1240x1240px · Phoenix ICON, 100° FOV · wide-field fundus photograph from neonatal ROP screening: 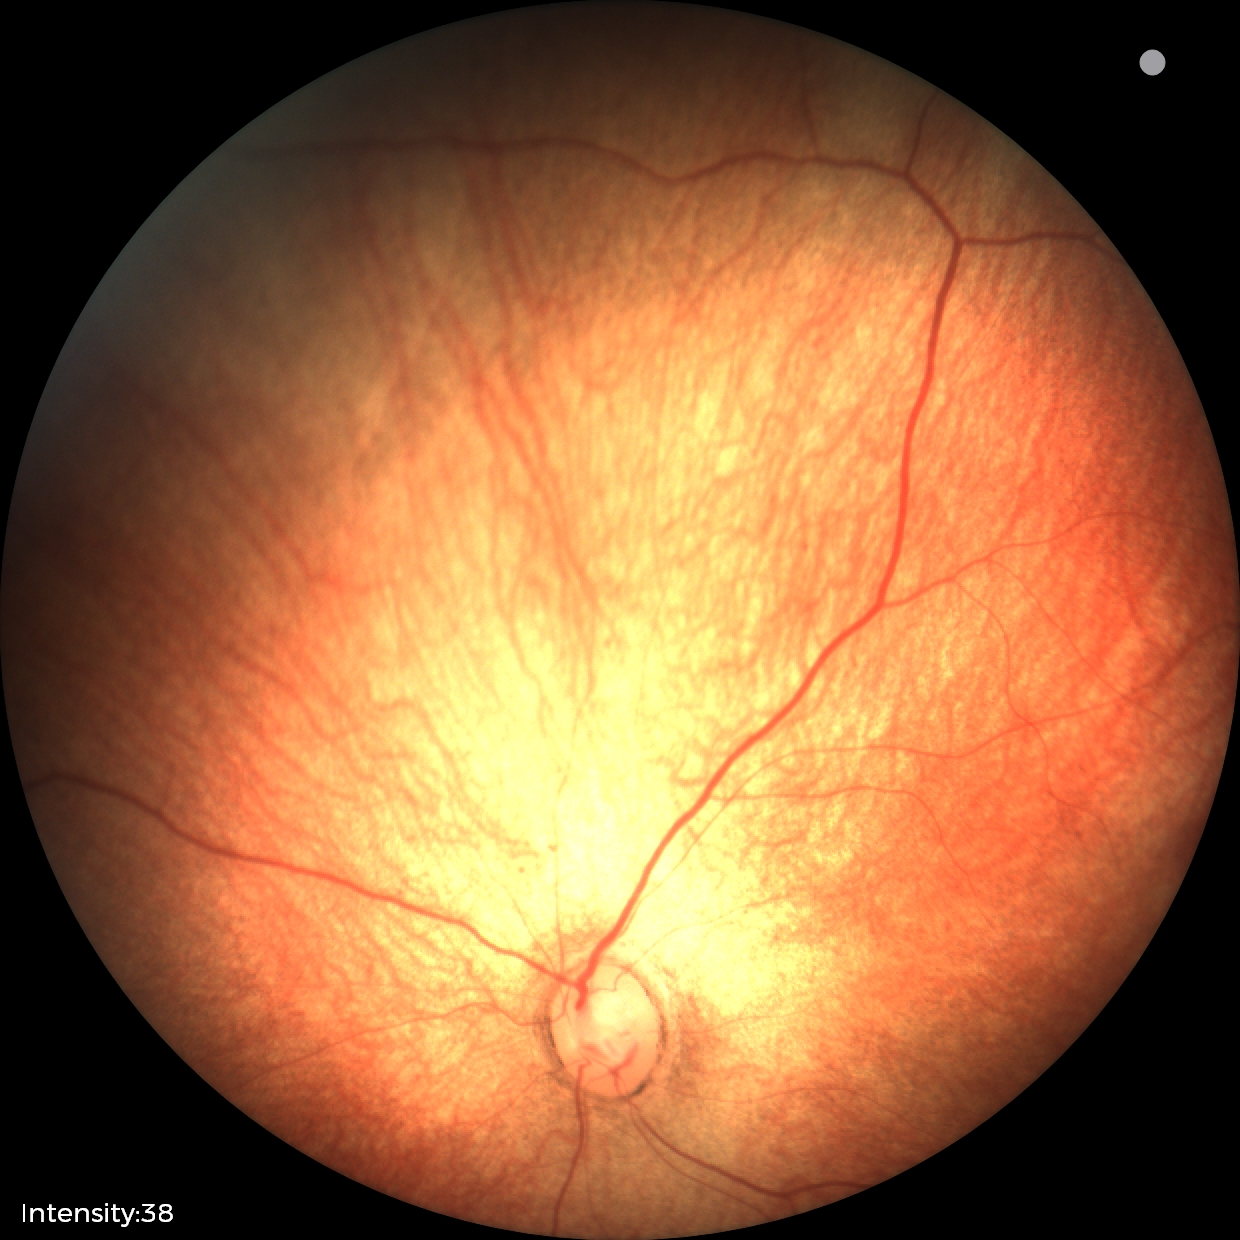
Normal screening examination.